Infant wide-field fundus photograph — 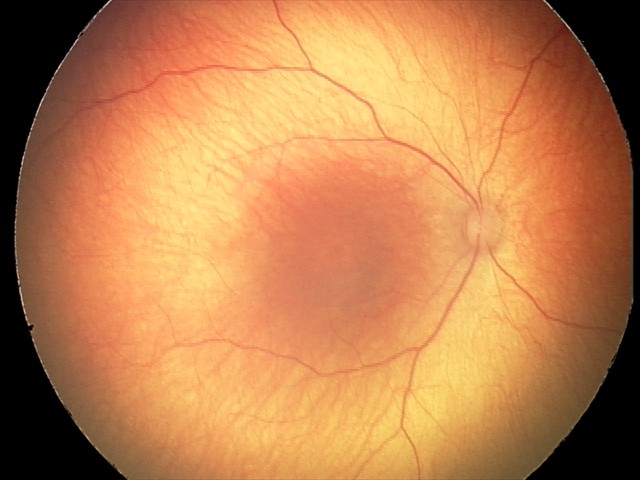 No retinal pathology identified on screening.